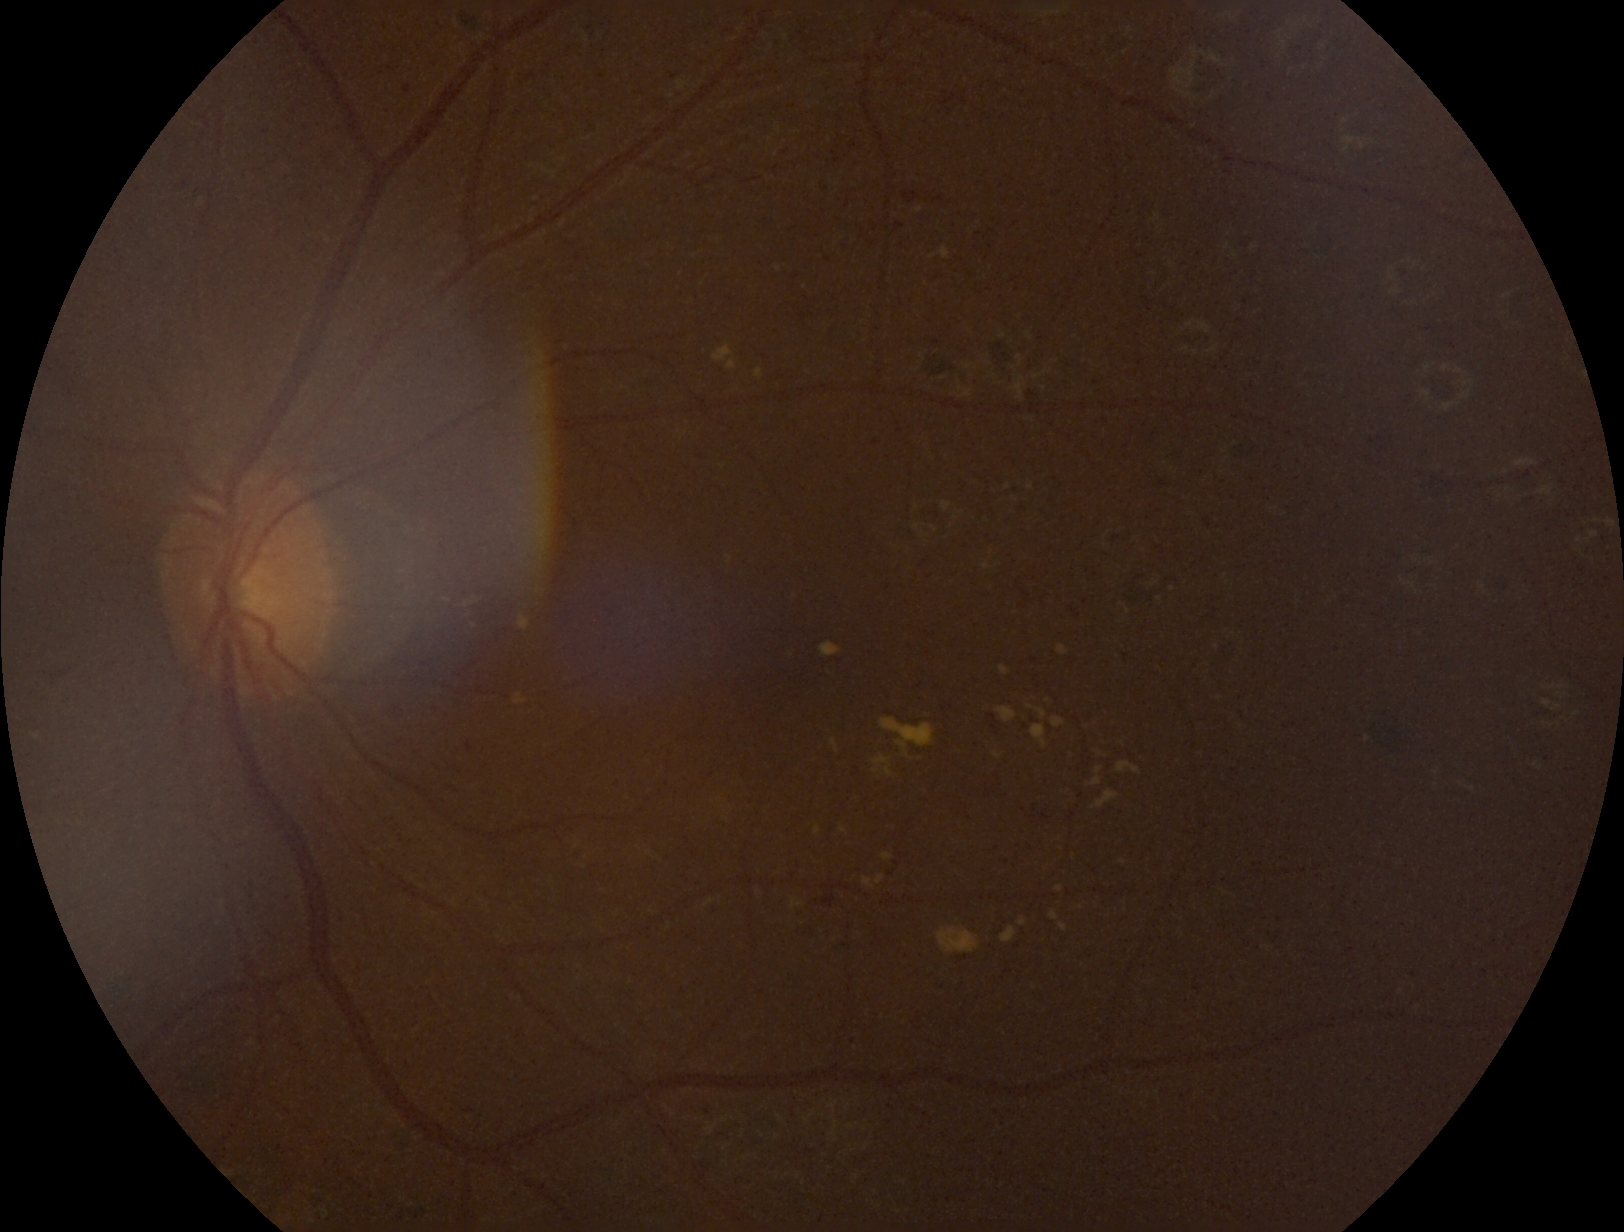
DR severity is grade 2 (moderate NPDR).